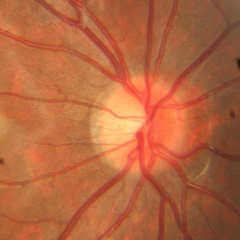
No signs of glaucoma.